Nonmydriatic; 45° field of view; camera: NIDEK AFC-230.
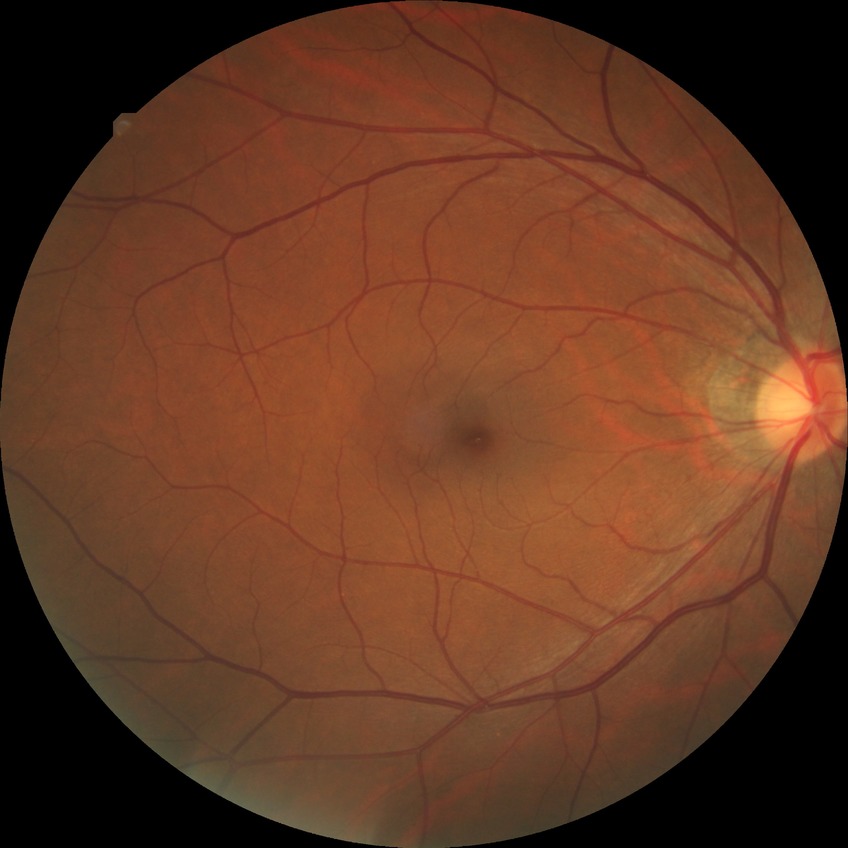 {"davis_grade": "no diabetic retinopathy (NDR)"}